Davis DR grading — 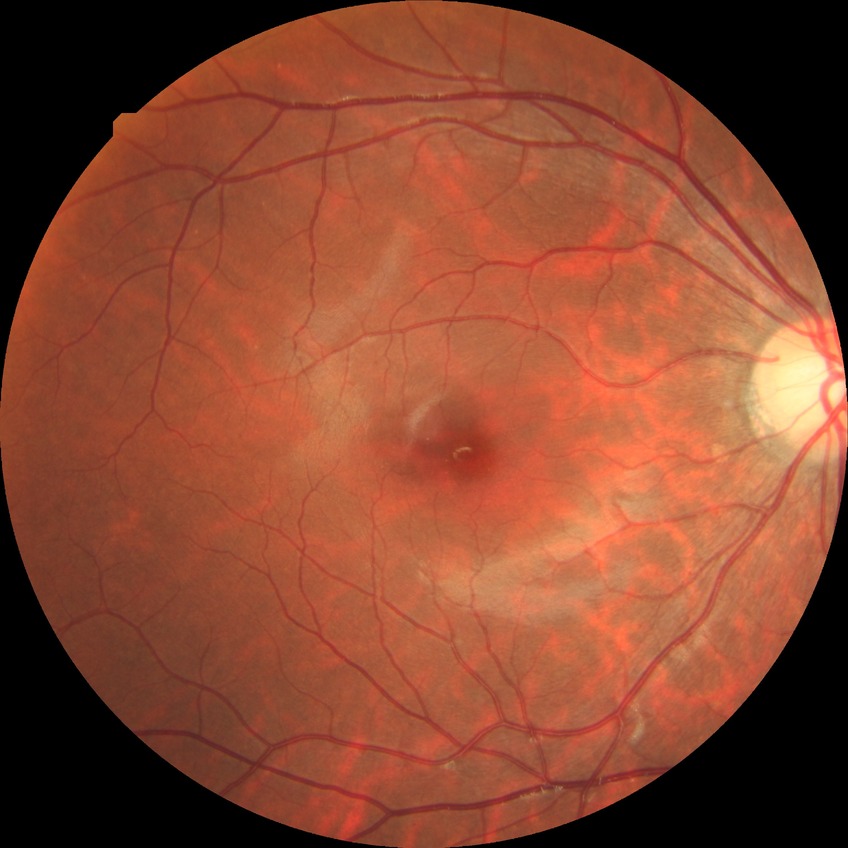 Assessment:
* diabetic retinopathy stage — no diabetic retinopathy